FOV: 45 degrees, 2212x1659
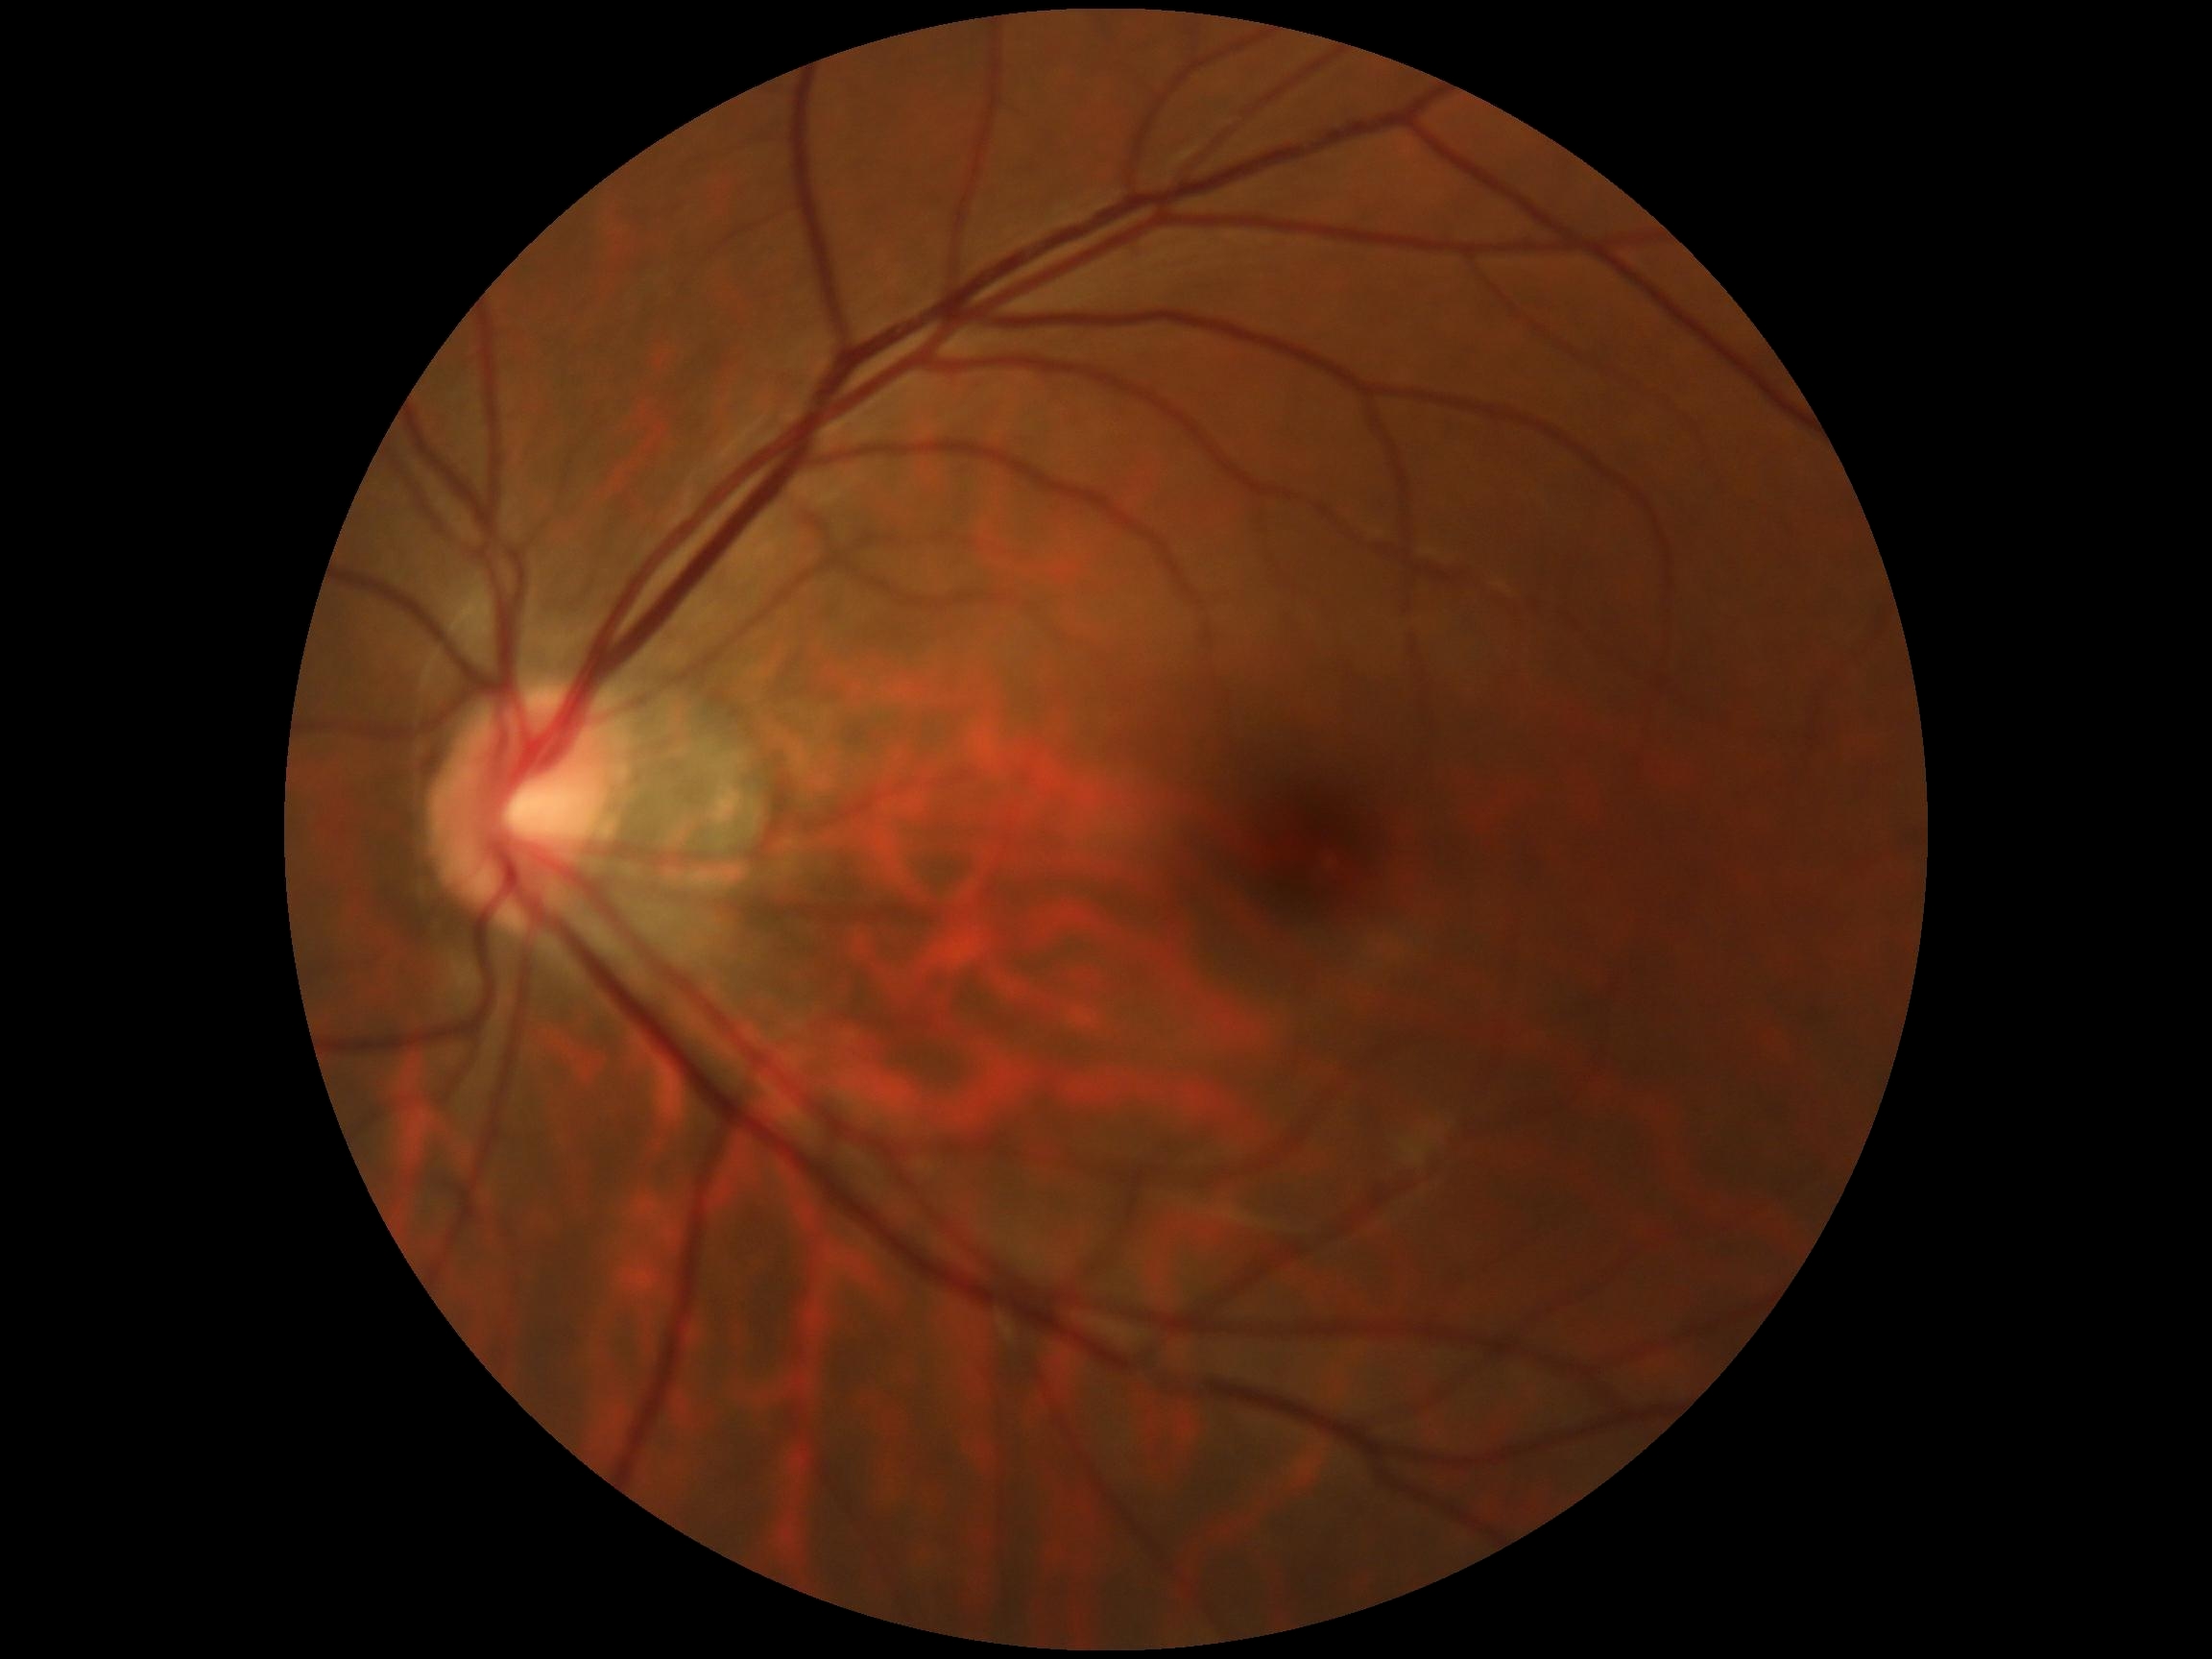
Findings:
- retinopathy grade: 0/4